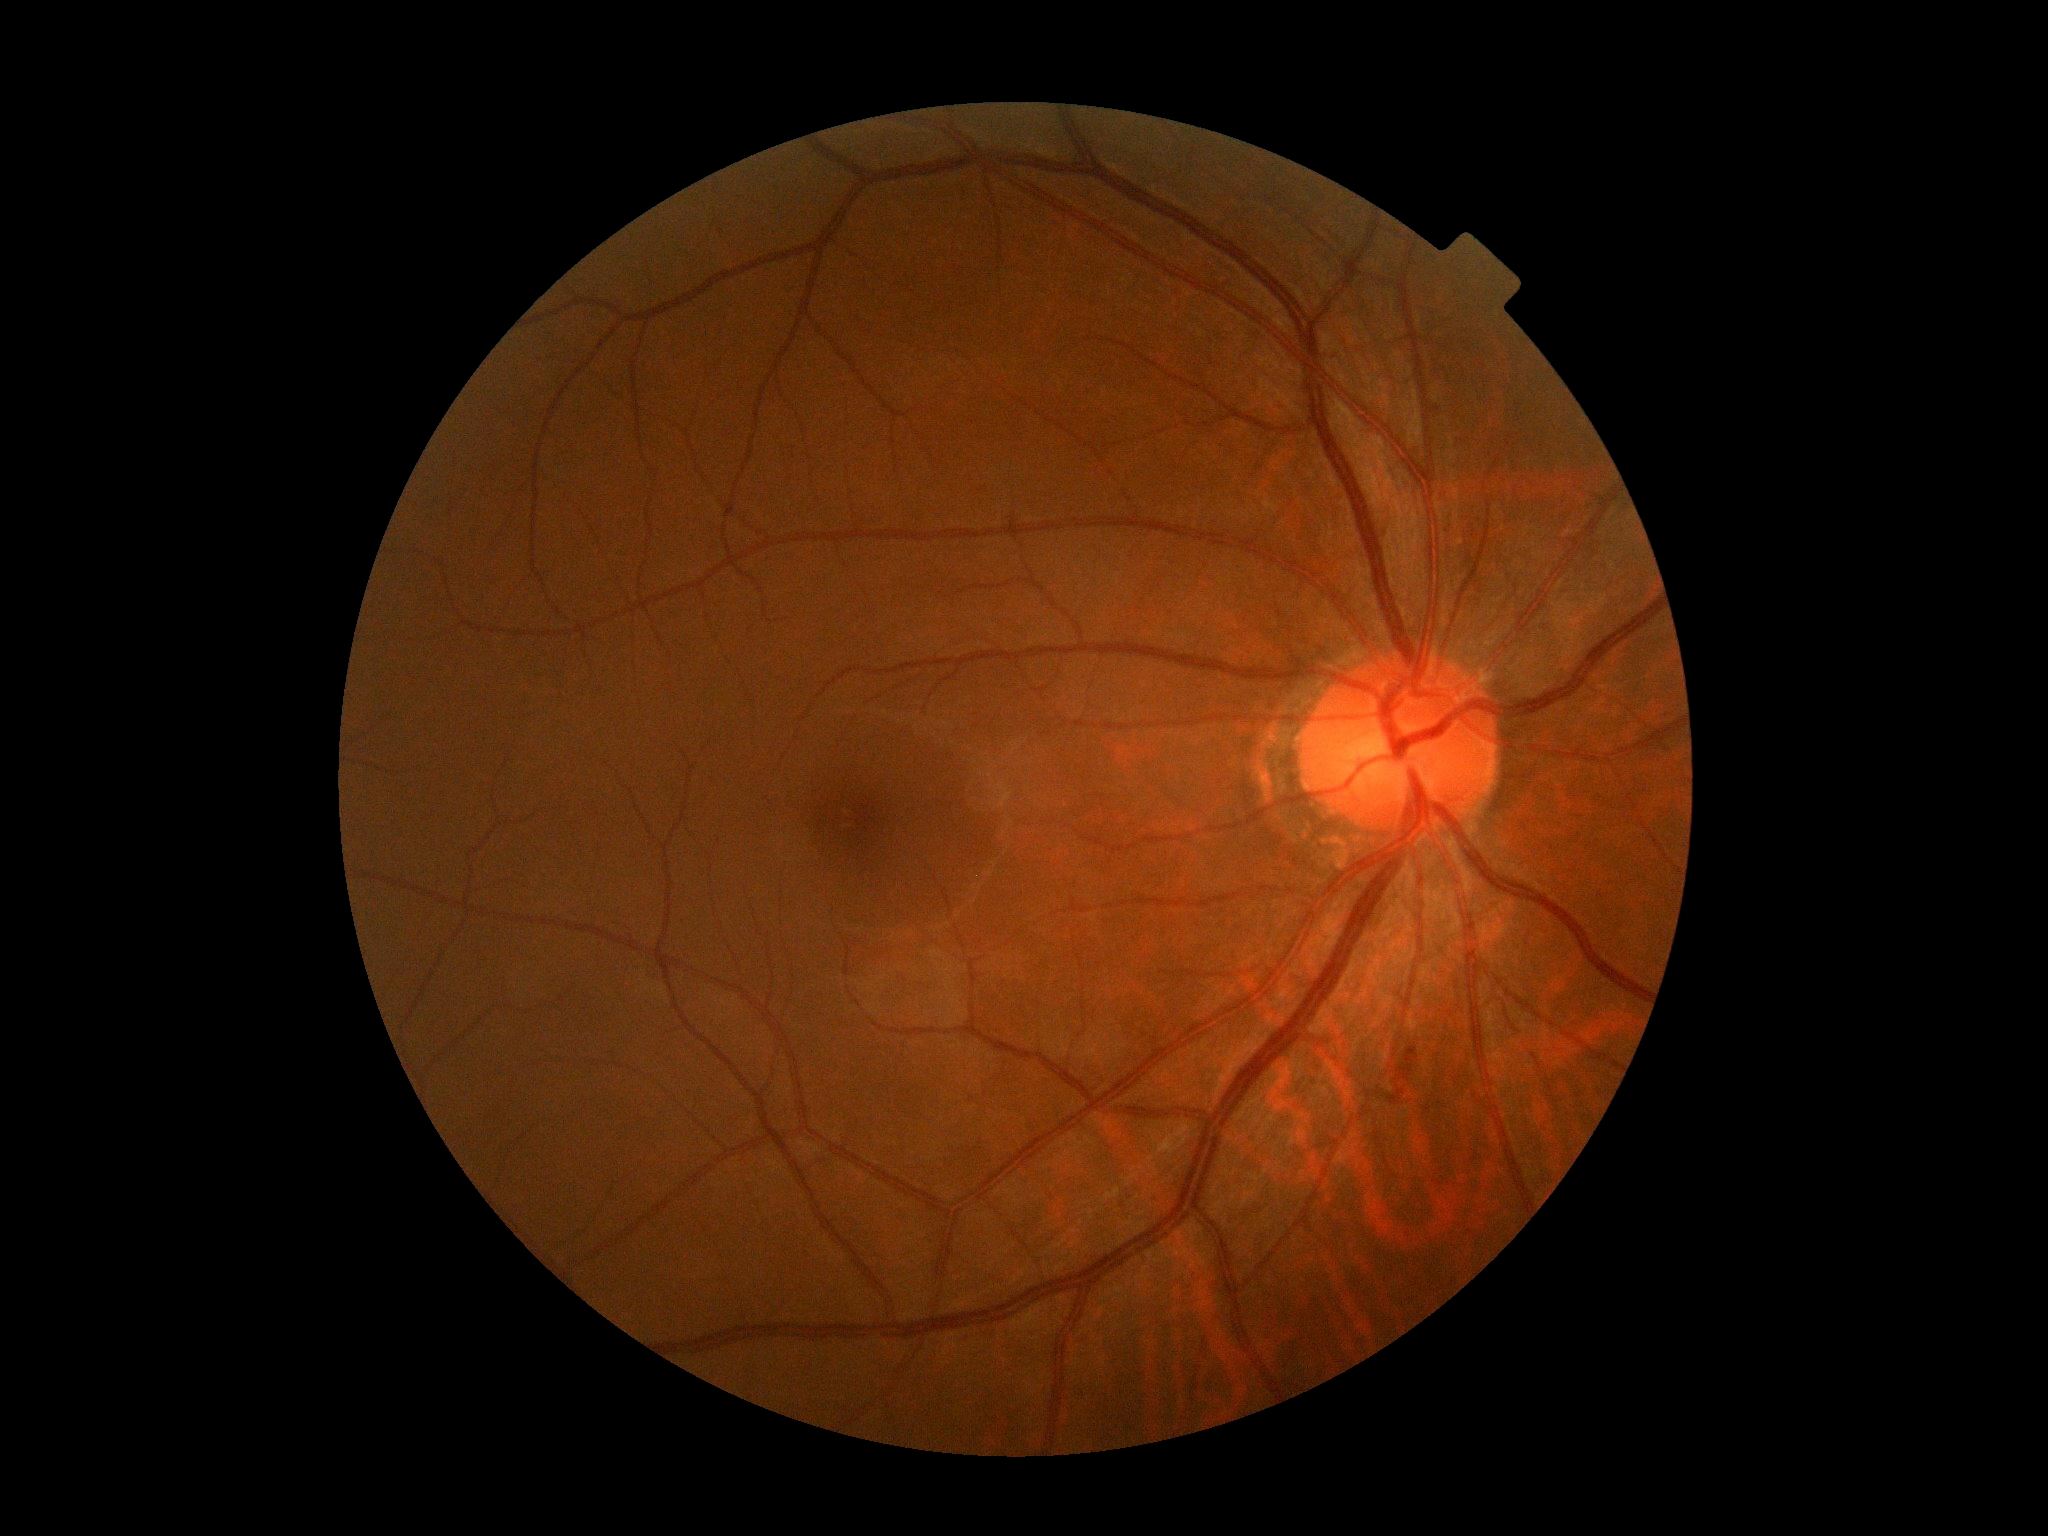
{"dr_category": "non-proliferative diabetic retinopathy", "dr_grade": "grade 2 (moderate NPDR)"}